Nonmydriatic fundus photograph · posterior pole color fundus photograph · DR severity per modified Davis staging: 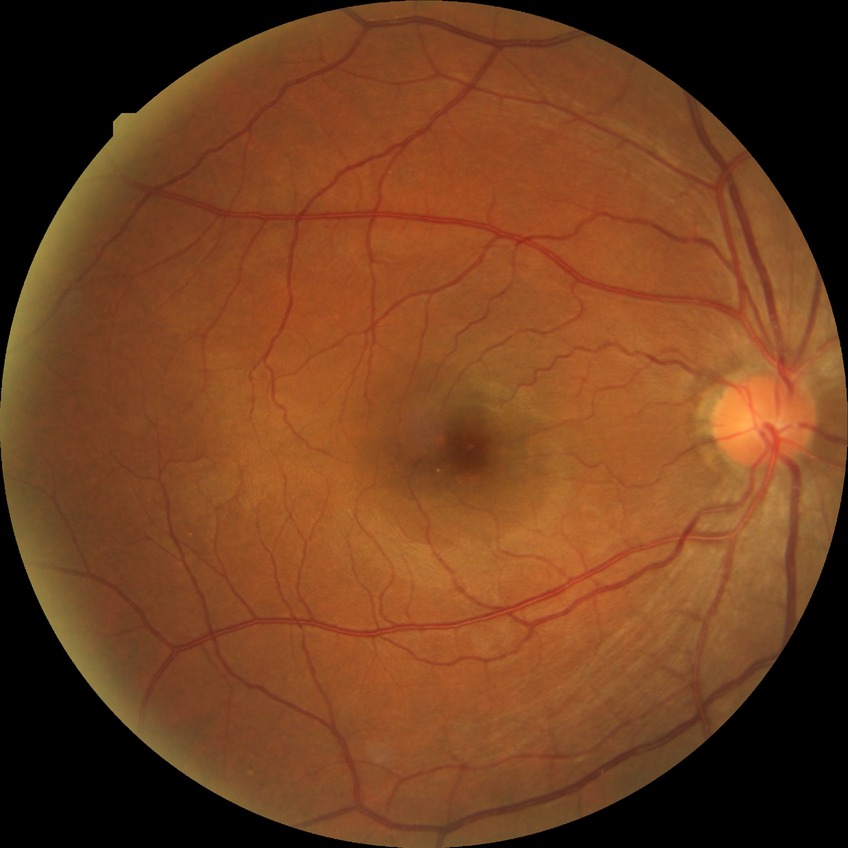

davis_grade: no diabetic retinopathy